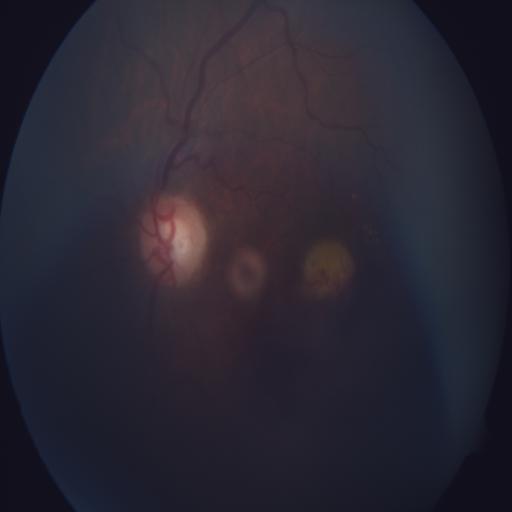 The image shows central serous retinopathy (CSR).